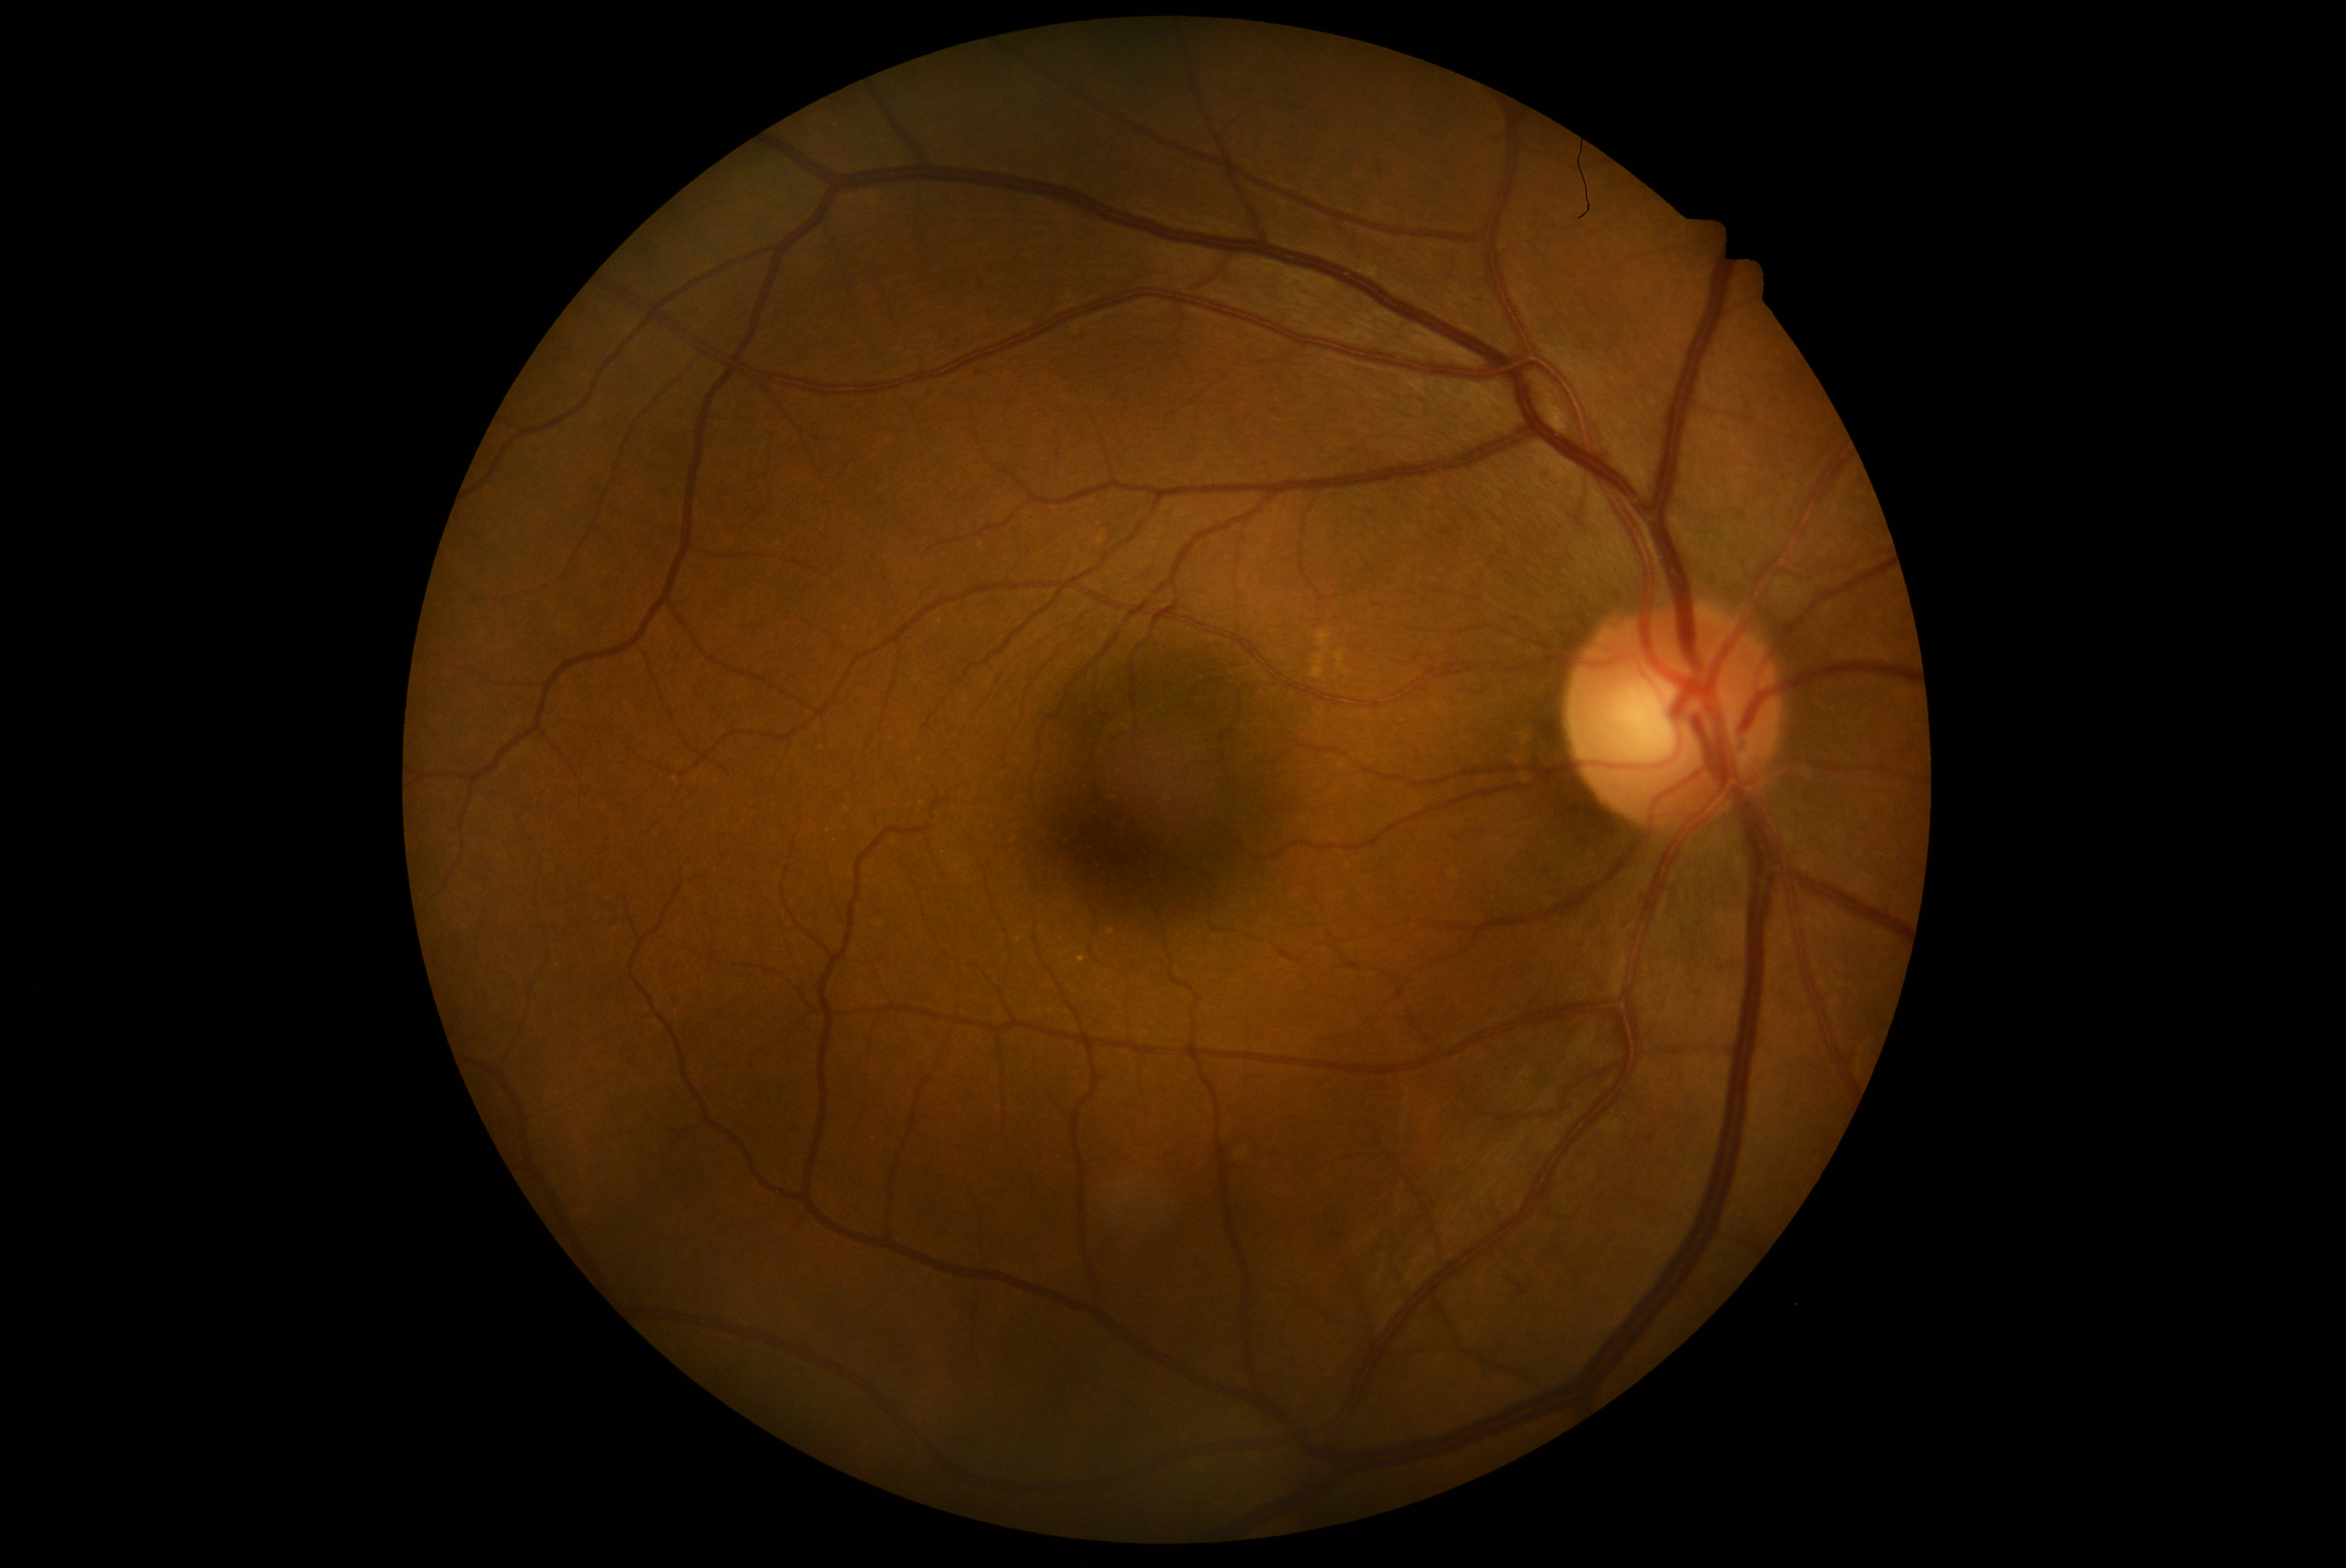 dr_grade: 1/4